Ultra-widefield (UWF) fundus image · 1924 x 1556 pixels:
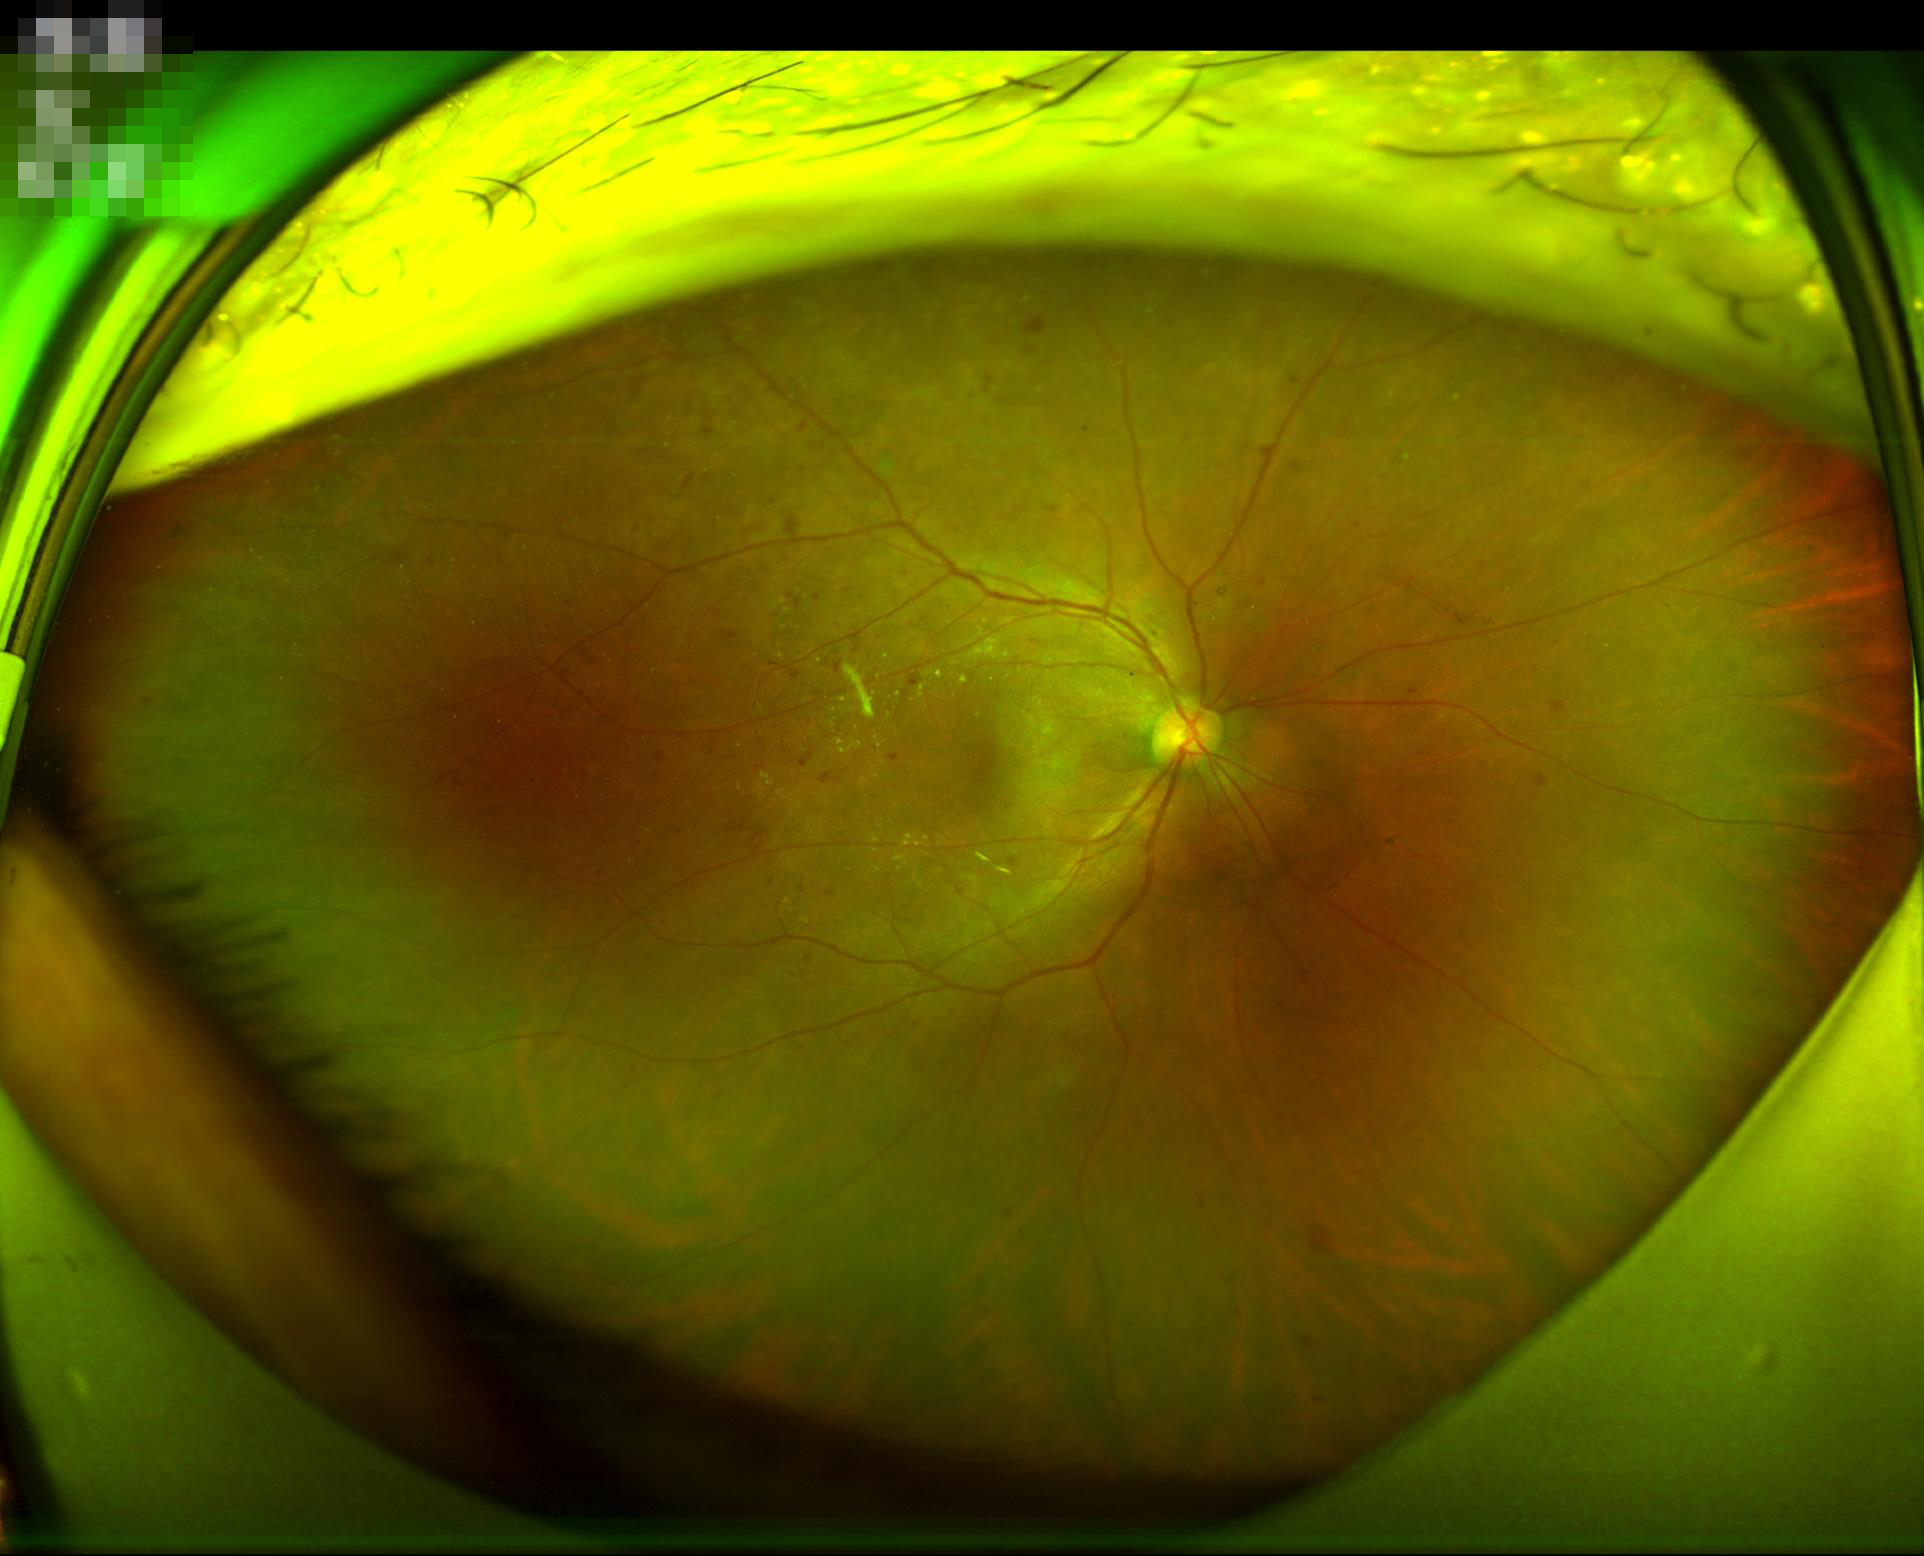
Quality grading: illumination: even and well-balanced; sharpness: optic disc, vessels, and background in focus; contrast: vessels and details readily distinguishable.